100° field of view (Phoenix ICON). Infant wide-field retinal image
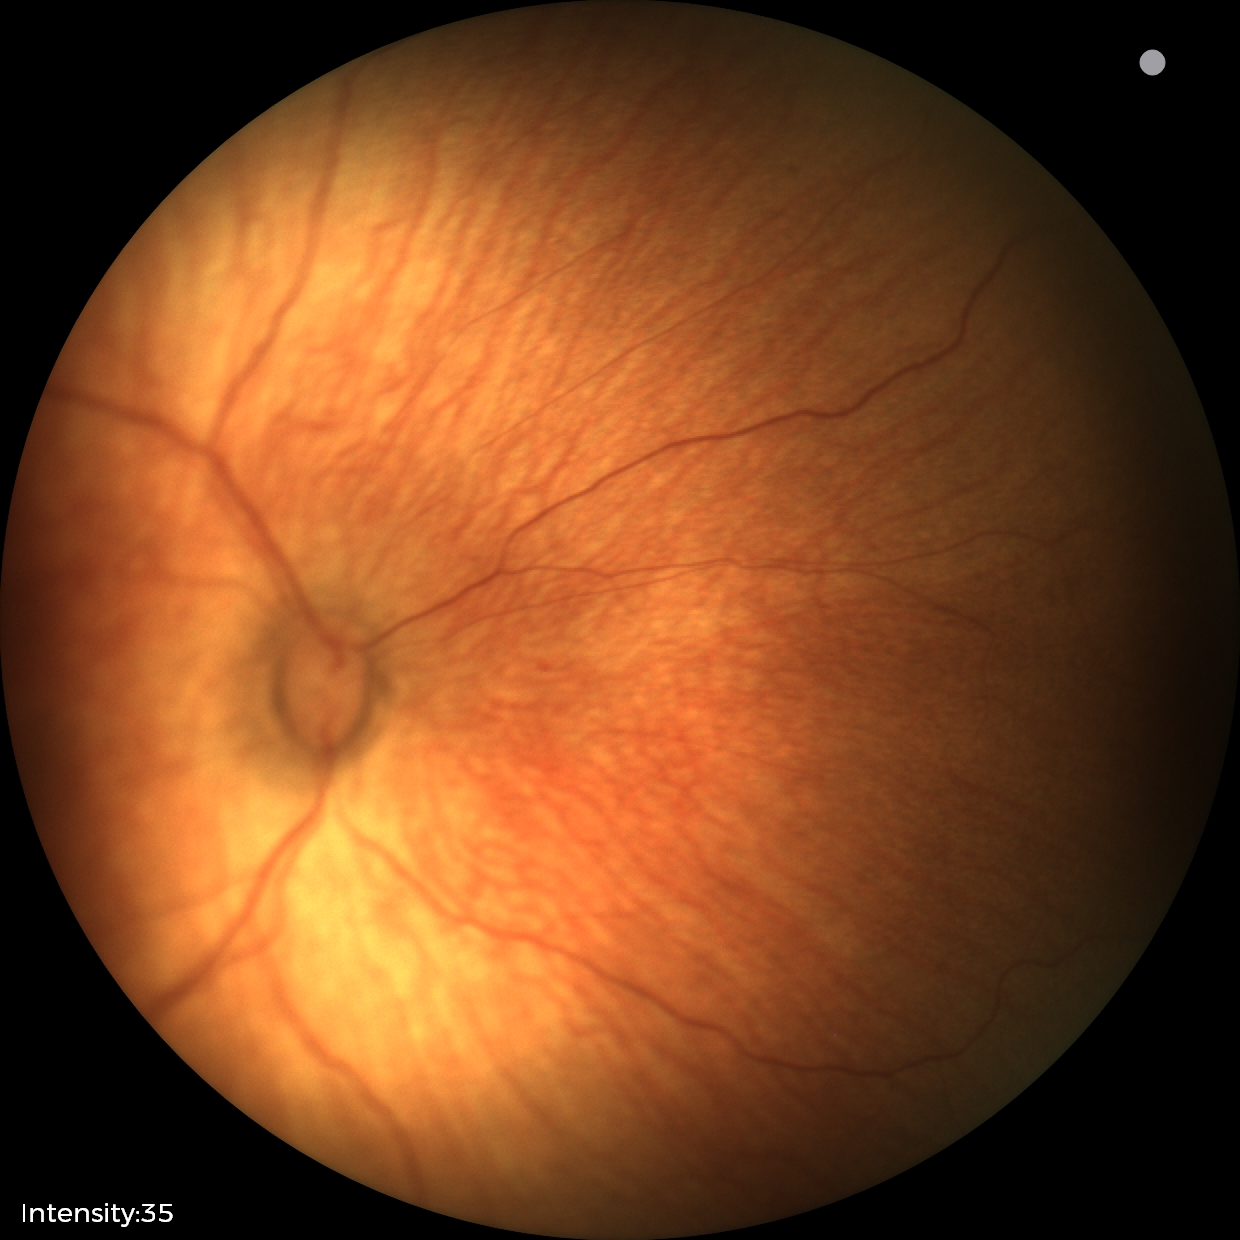

From an examination with diagnosis of status post ROP. Without plus disease.